Nonmydriatic fundus photograph:
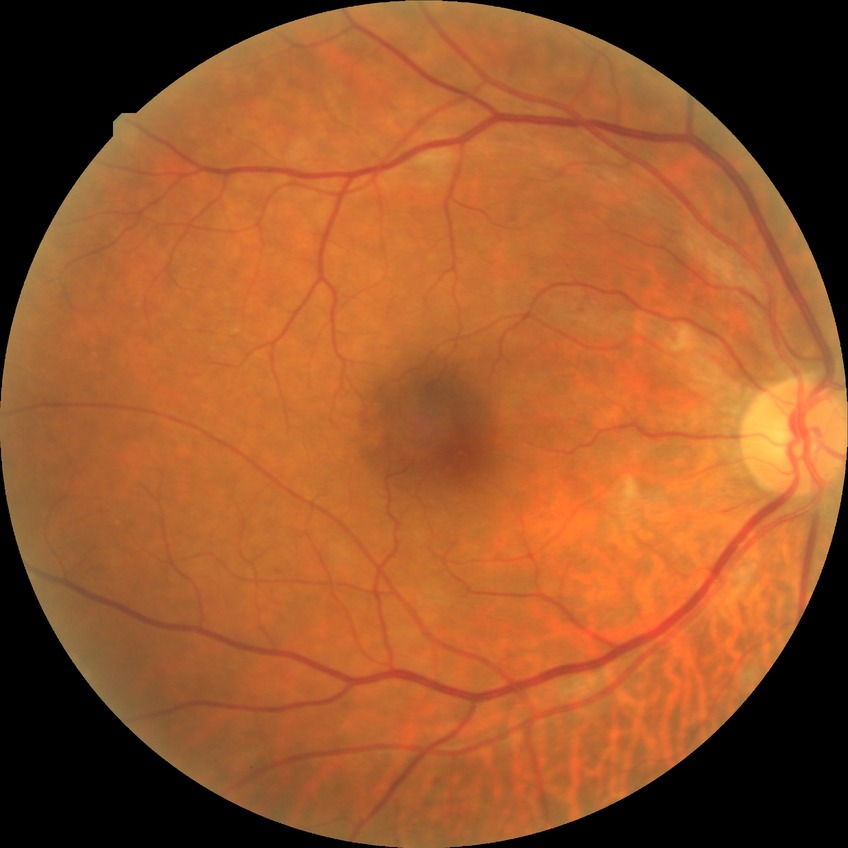 Diabetic retinopathy (DR) is pre-proliferative diabetic retinopathy (PPDR).